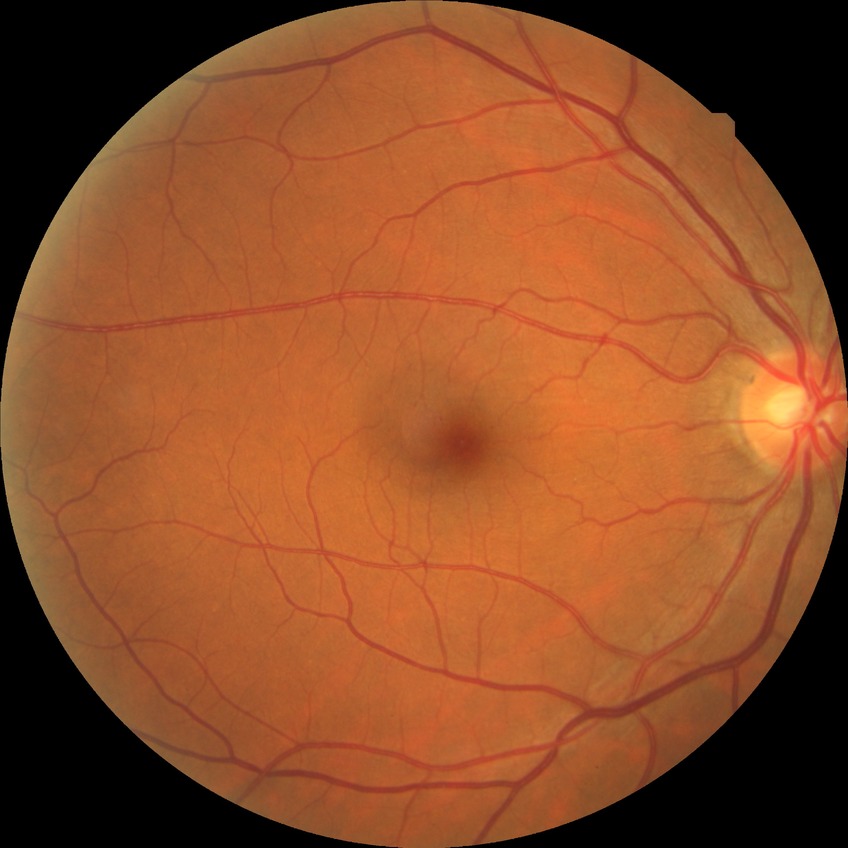

Diabetic retinopathy (DR) is no diabetic retinopathy (NDR).